45° FOV:
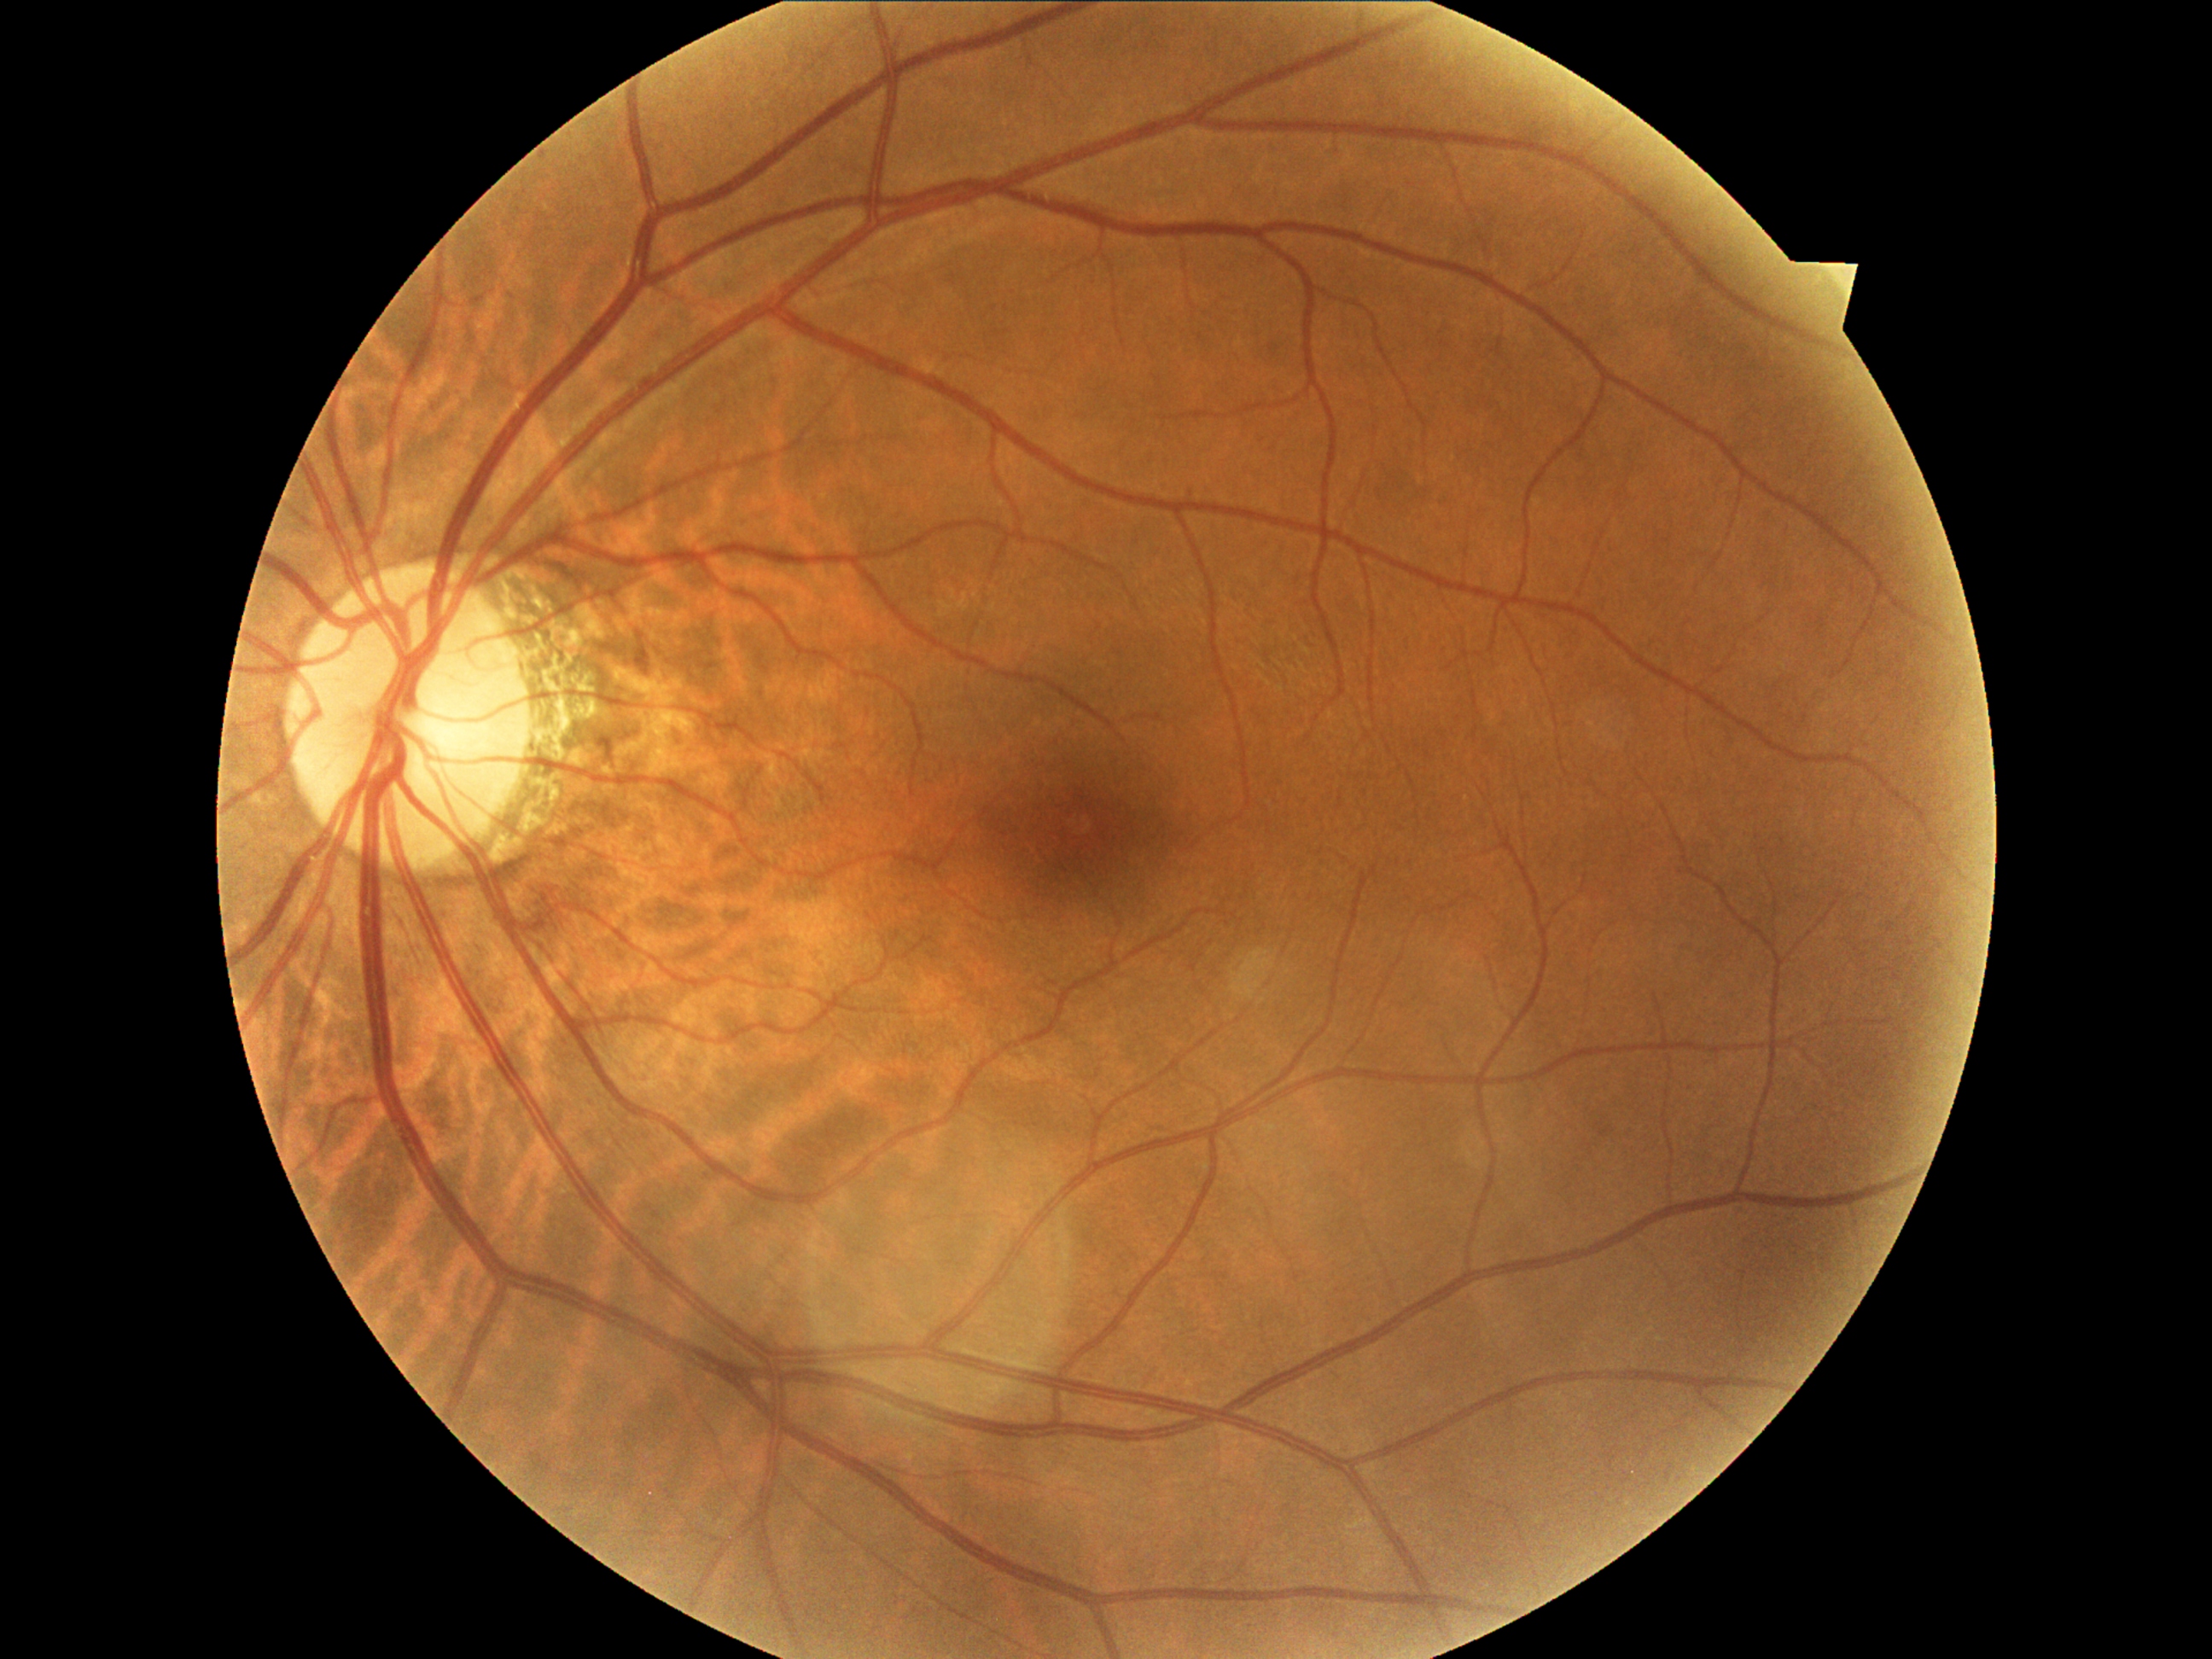

Diabetic retinopathy grade: 2/4.